Color fundus image. Graded on the modified Davis scale.
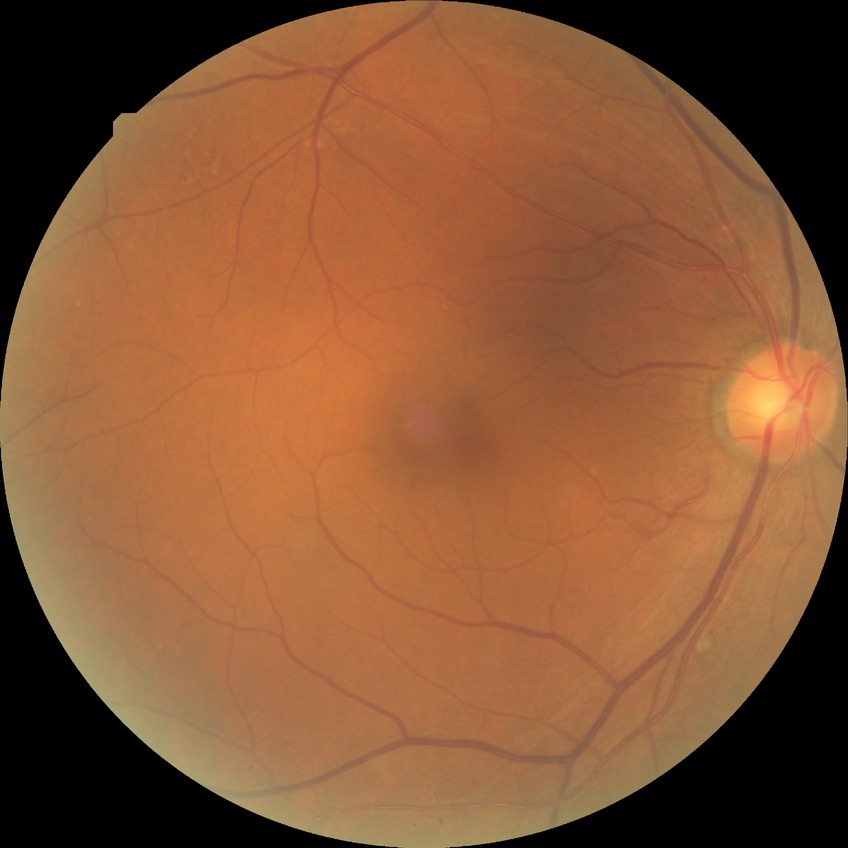 – diabetic retinopathy (DR) — simple diabetic retinopathy (SDR)